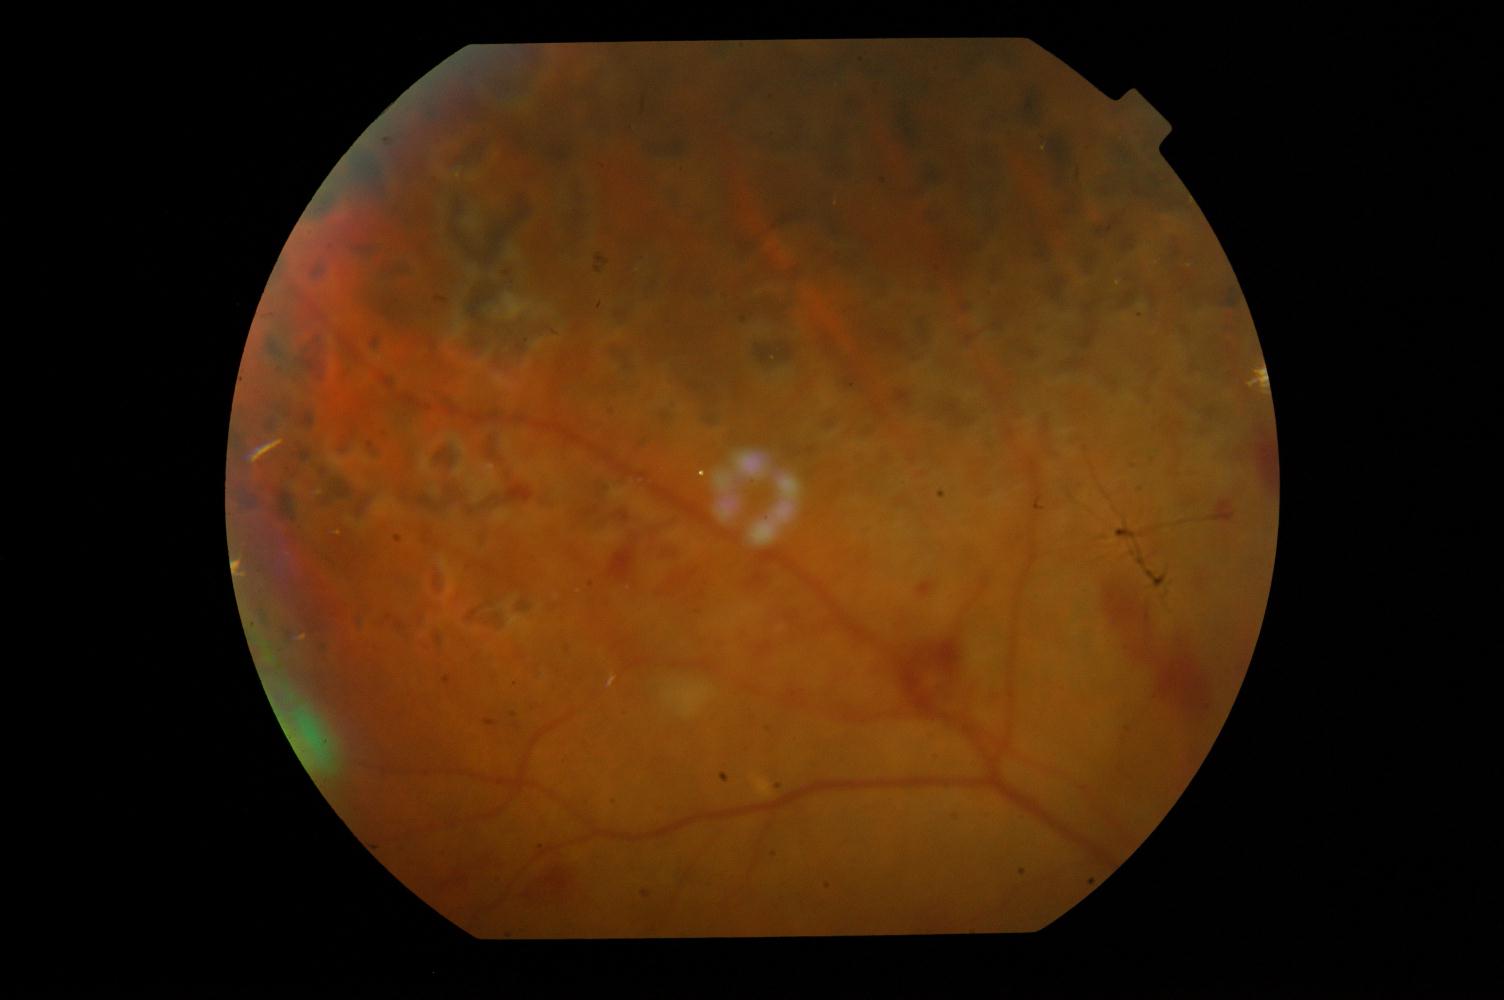 Abnormalities: diabetic retinopathy.